Retinal fundus photograph: 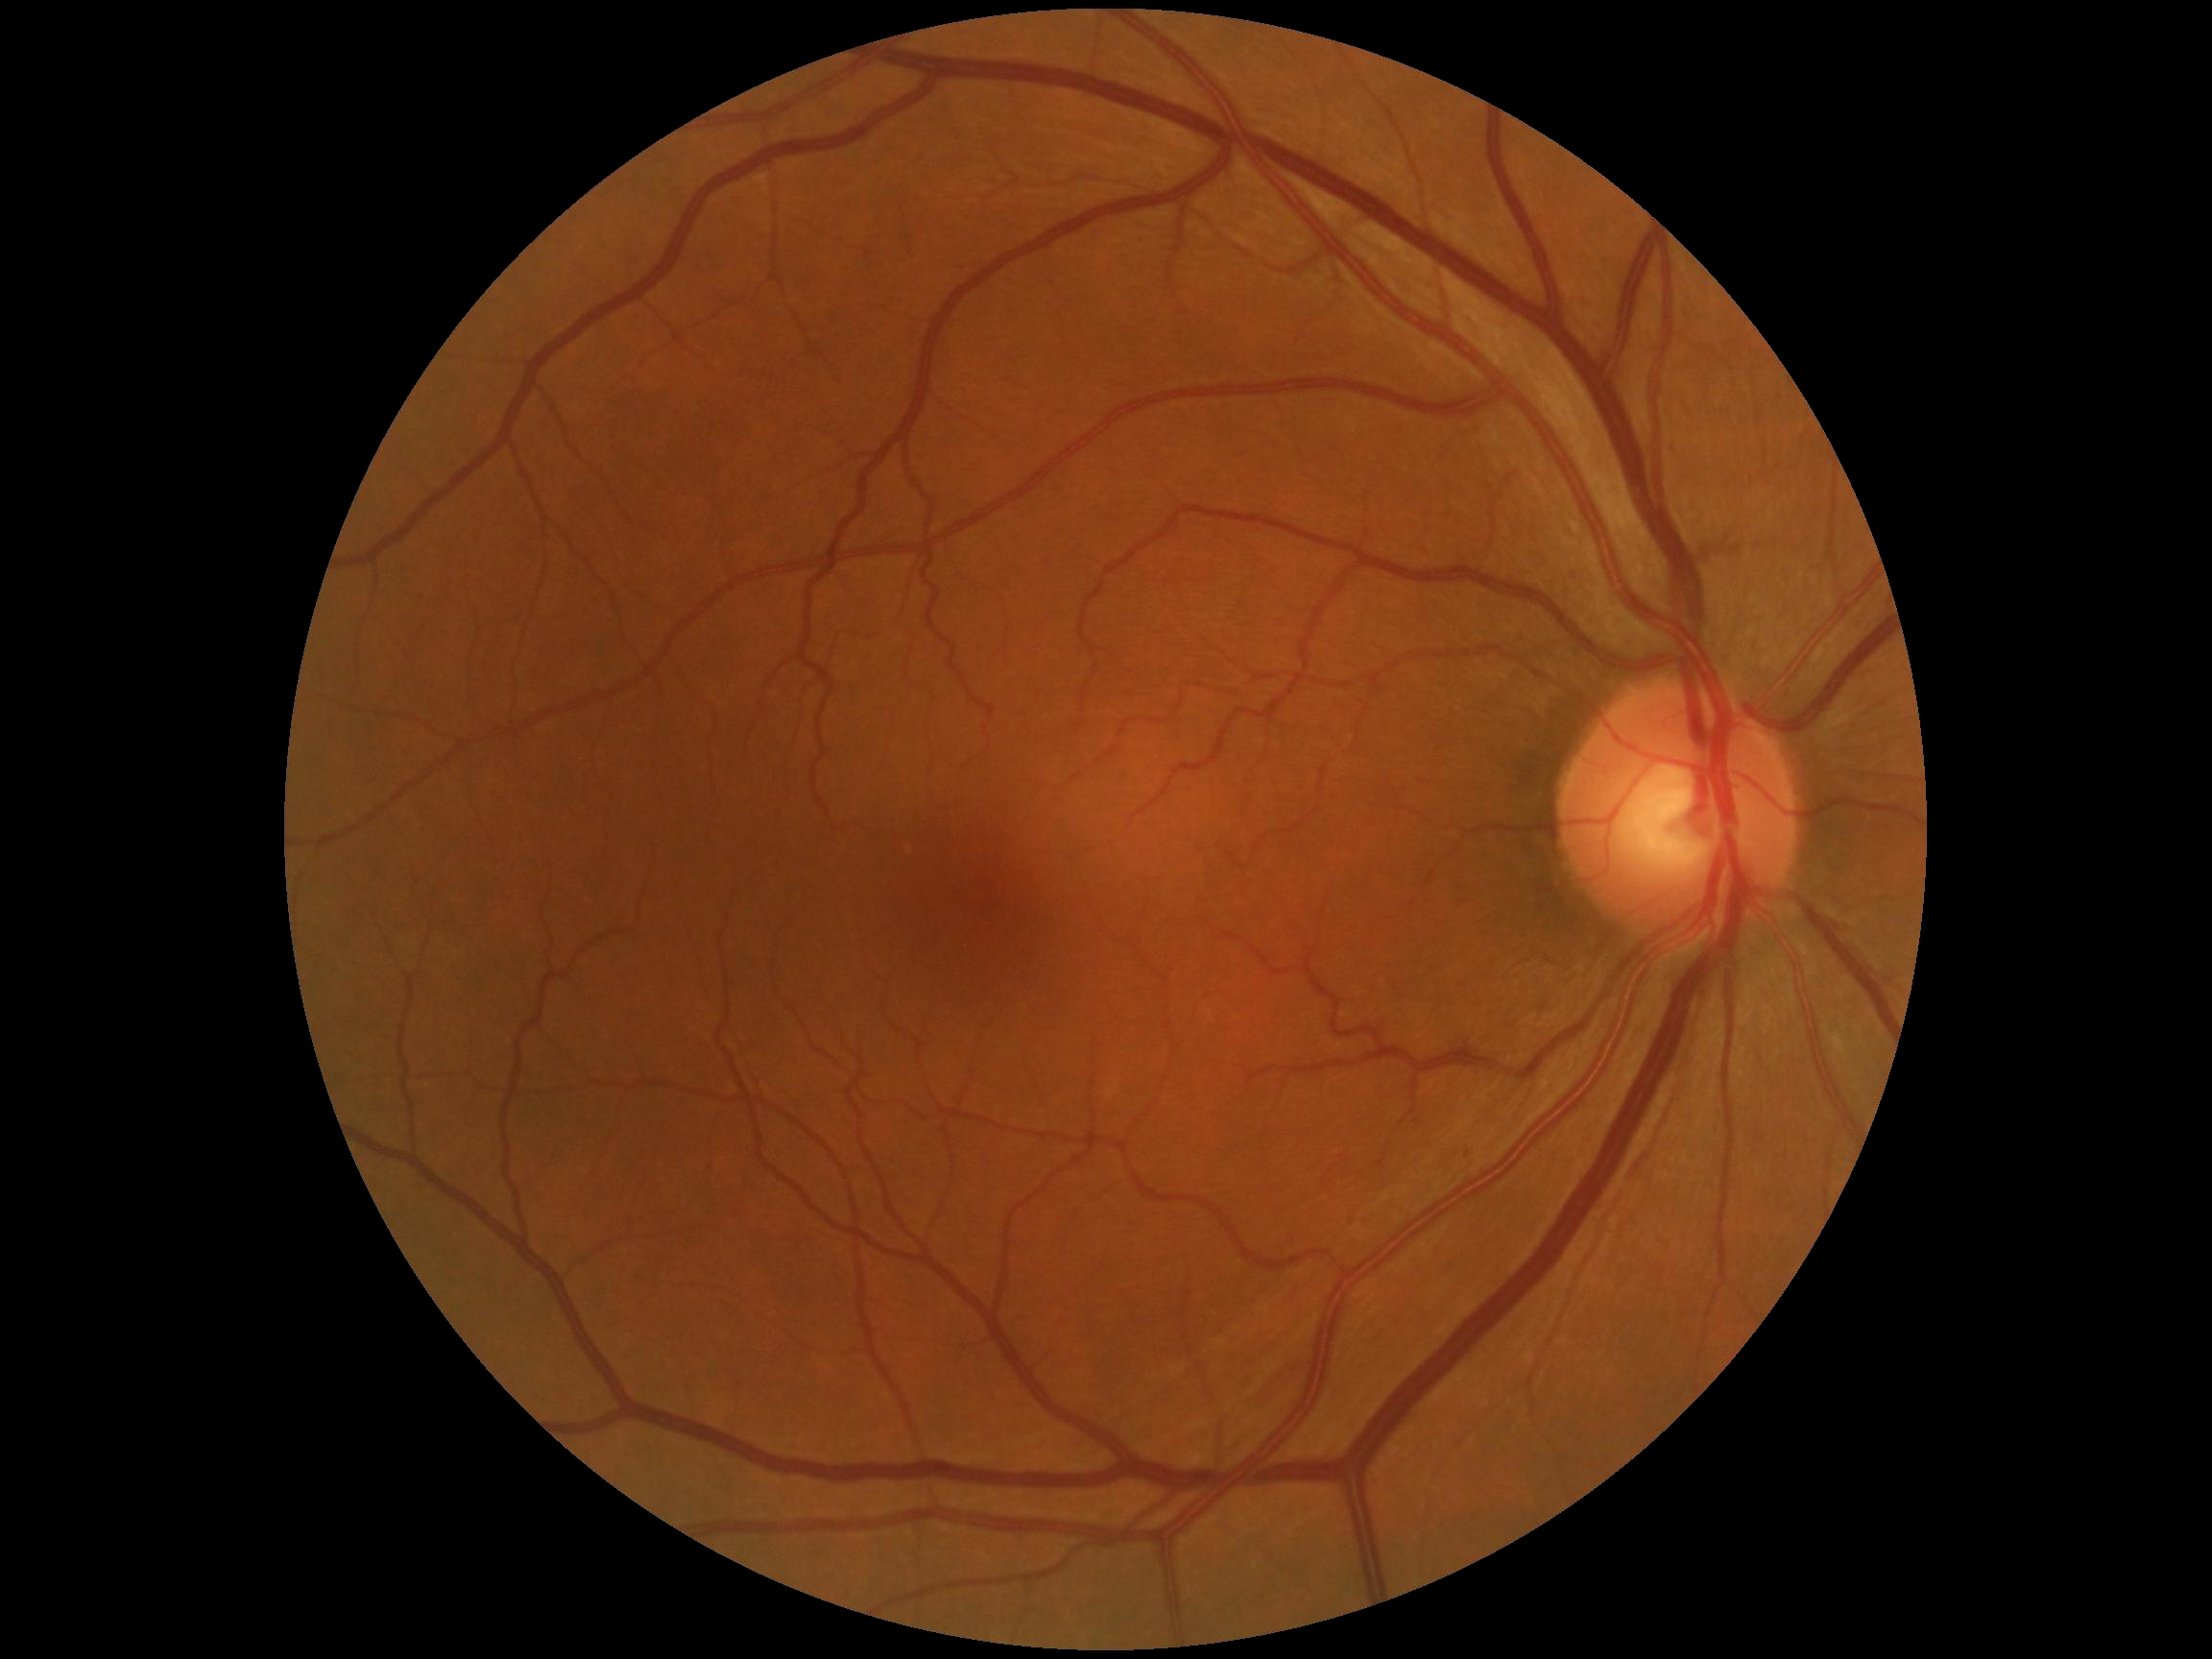
DR stage: no apparent diabetic retinopathy (grade 0).